45-degree field of view, retinal fundus photograph, image size 2352x1568
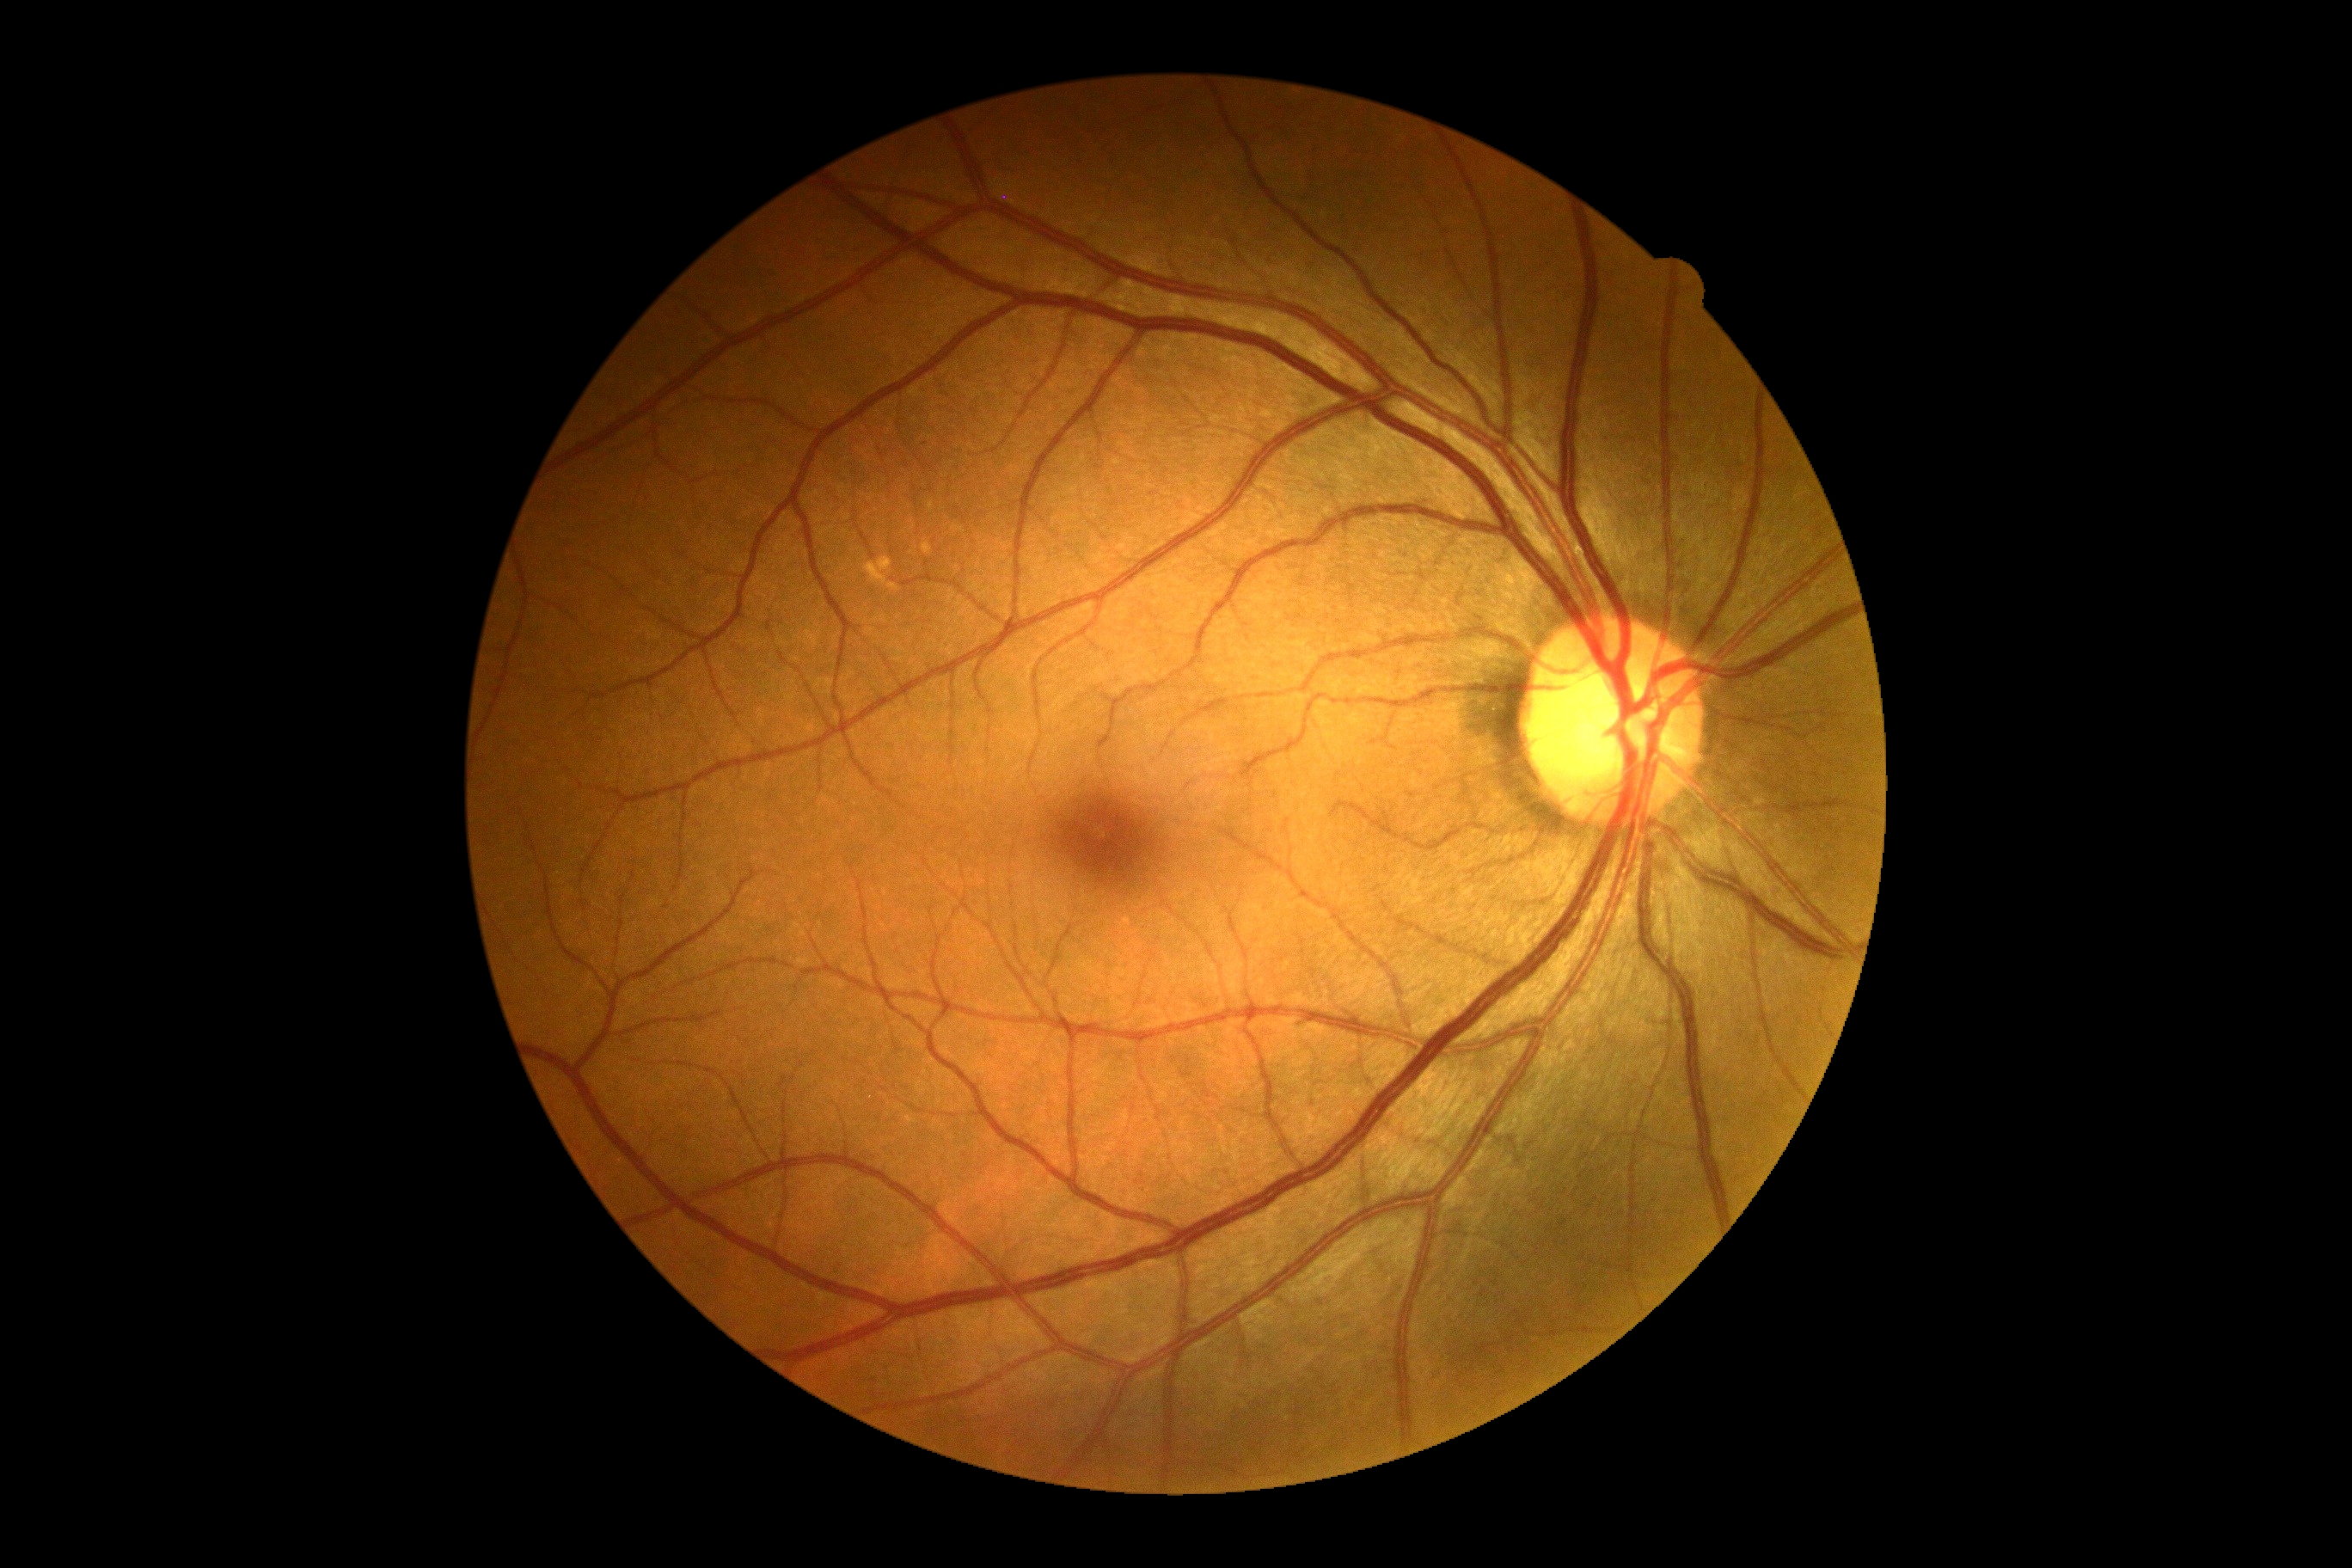

Diabetic retinopathy (DR) is 0/4. No apparent diabetic retinopathy.